Modified Davis classification · fundus photo:
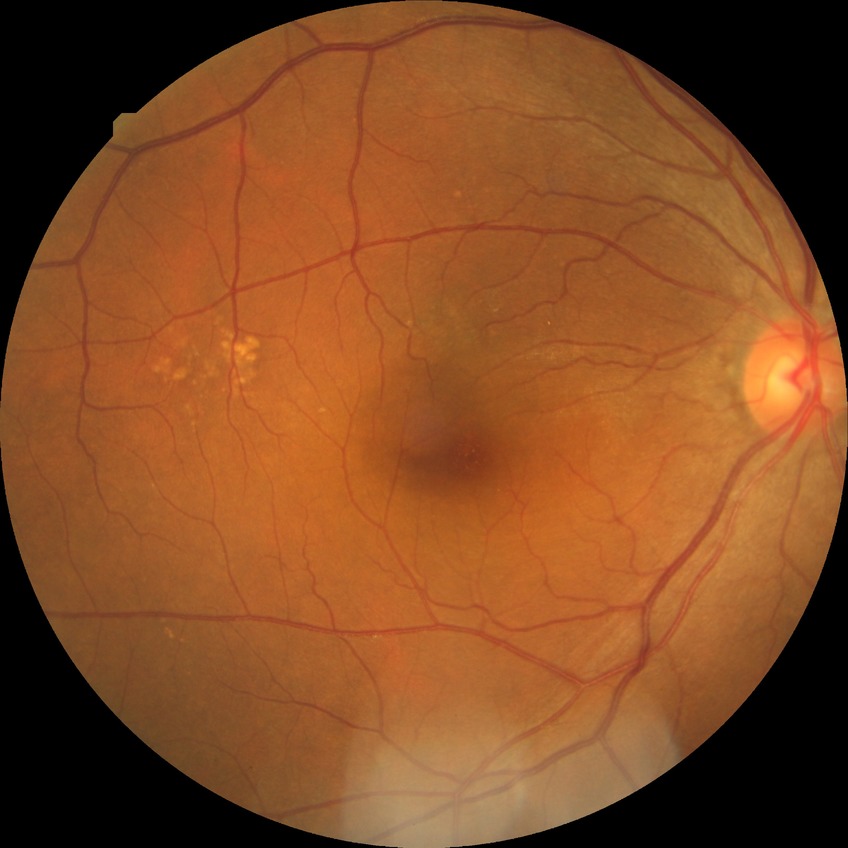

diabetic retinopathy (DR)=no diabetic retinopathy (NDR).